CFP. Image size 2352x1568.
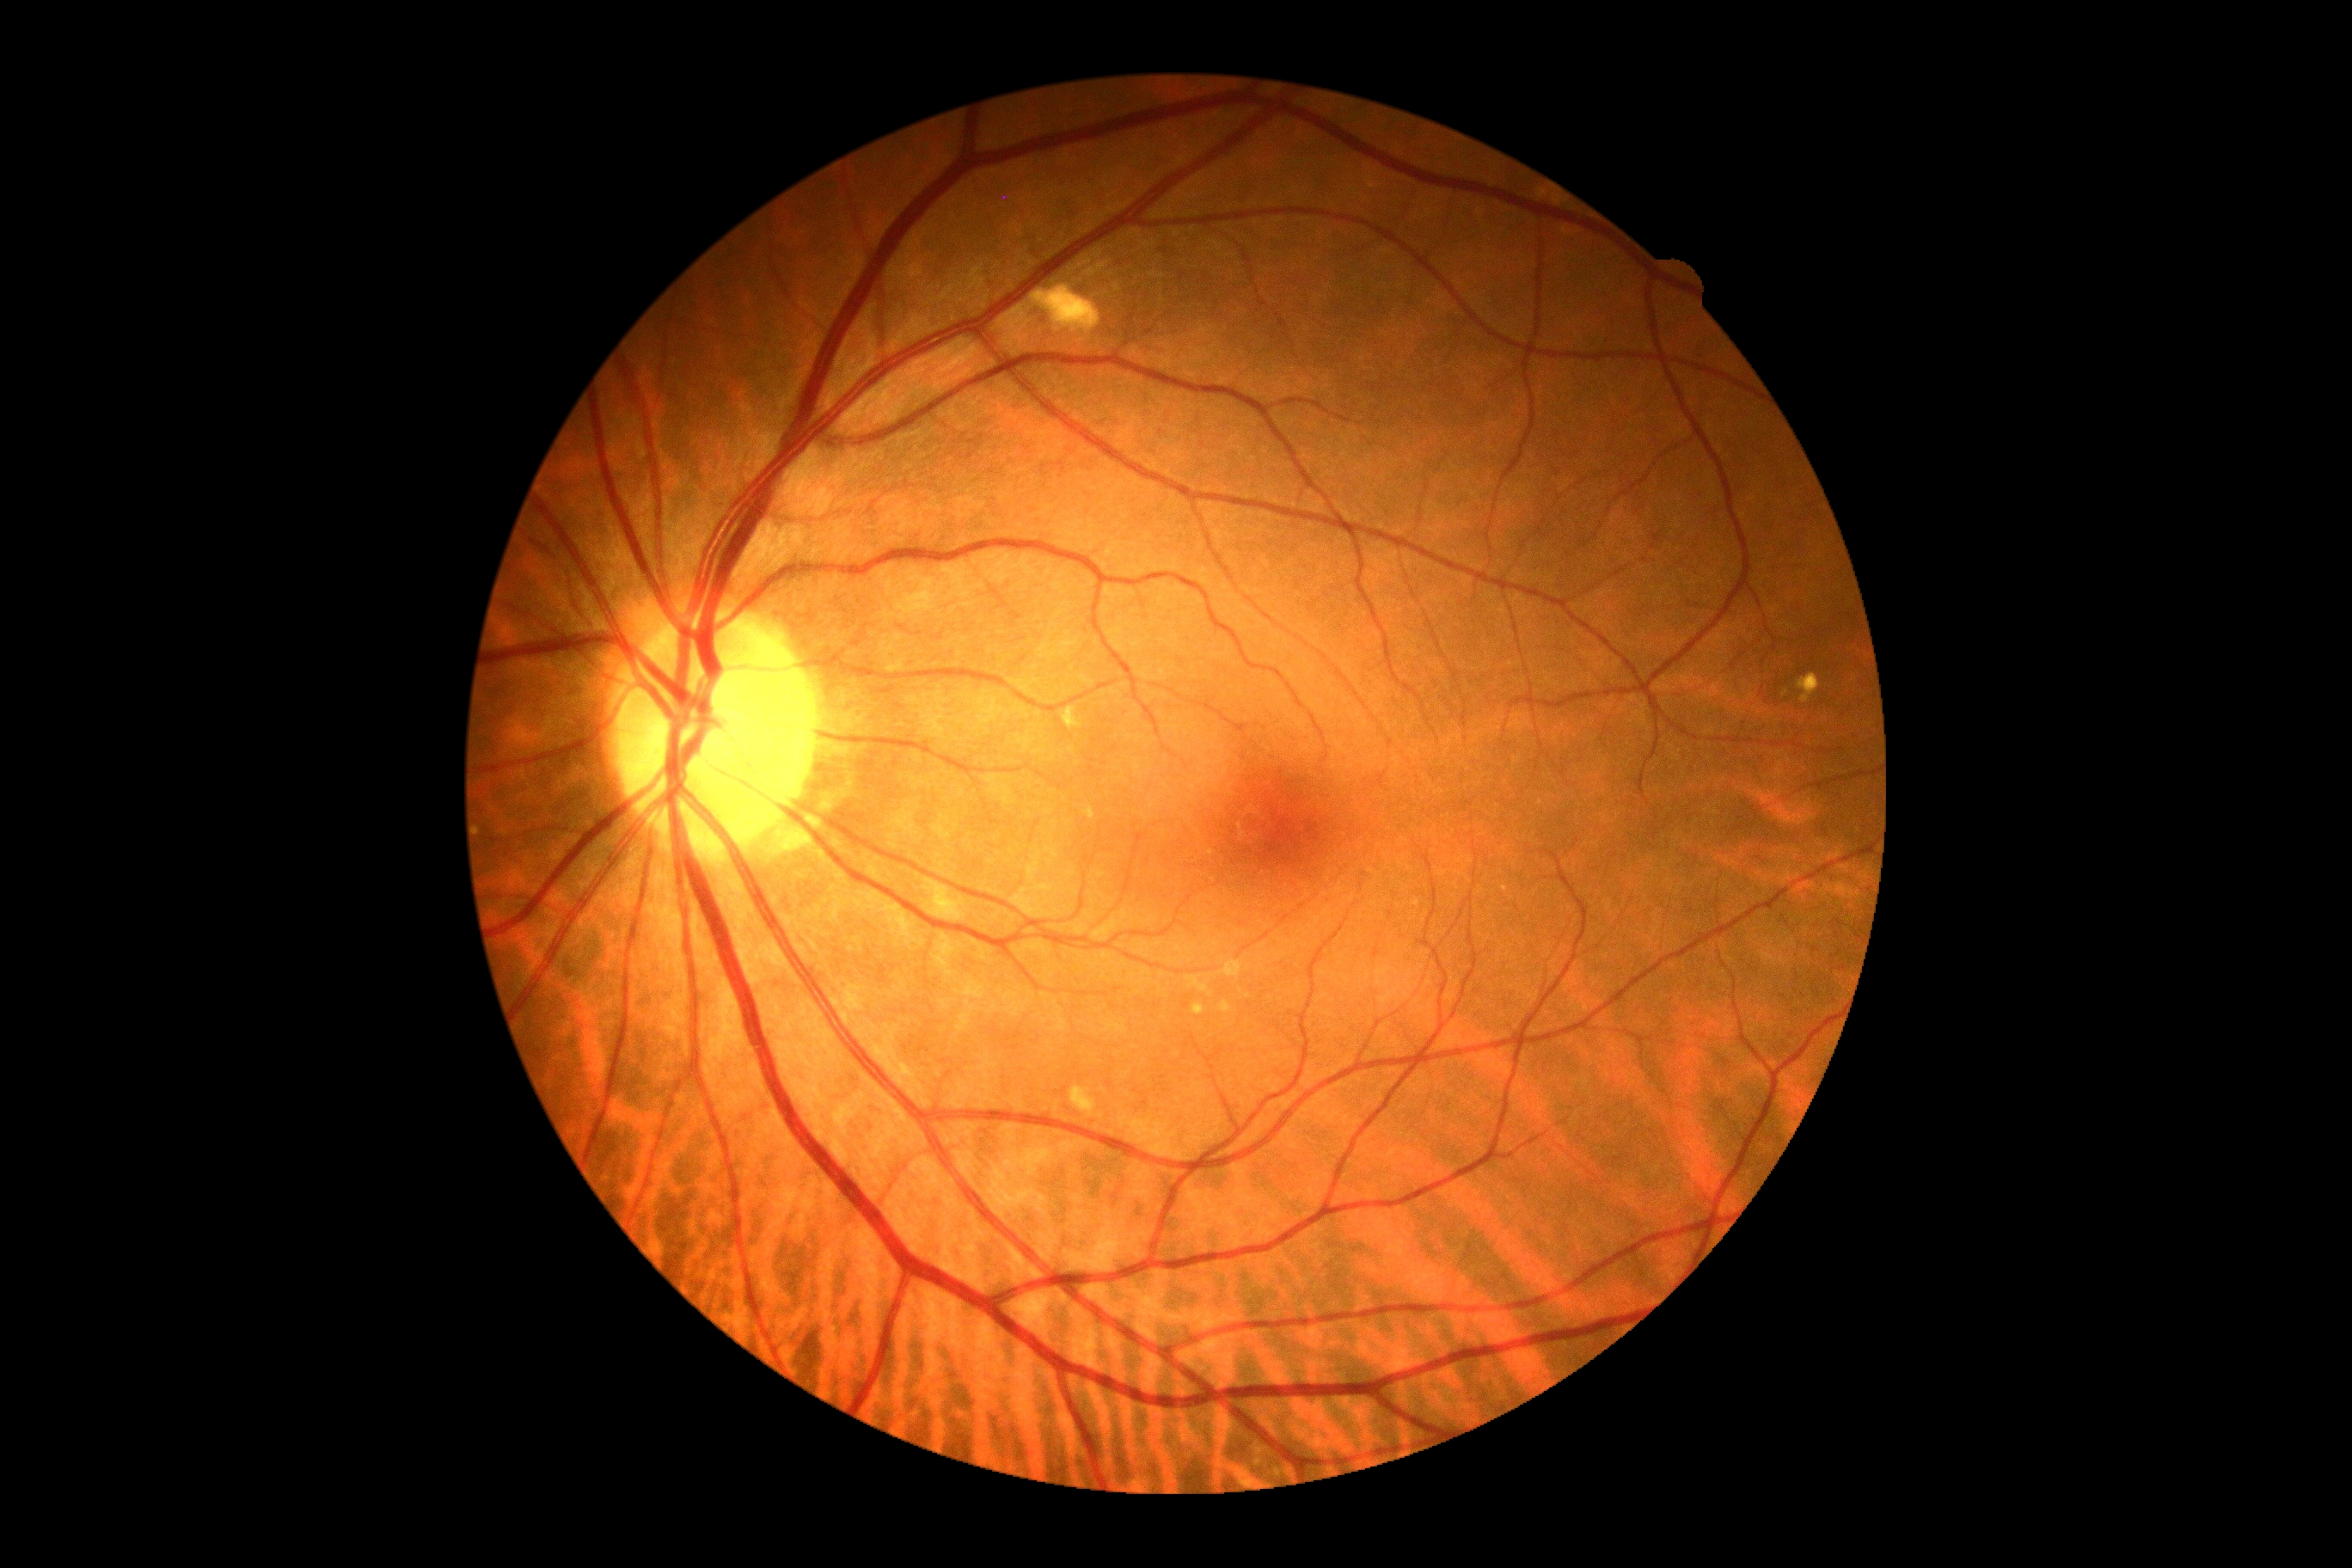 DR impression=negative for DR; DR stage=0 — no visible signs of diabetic retinopathy.